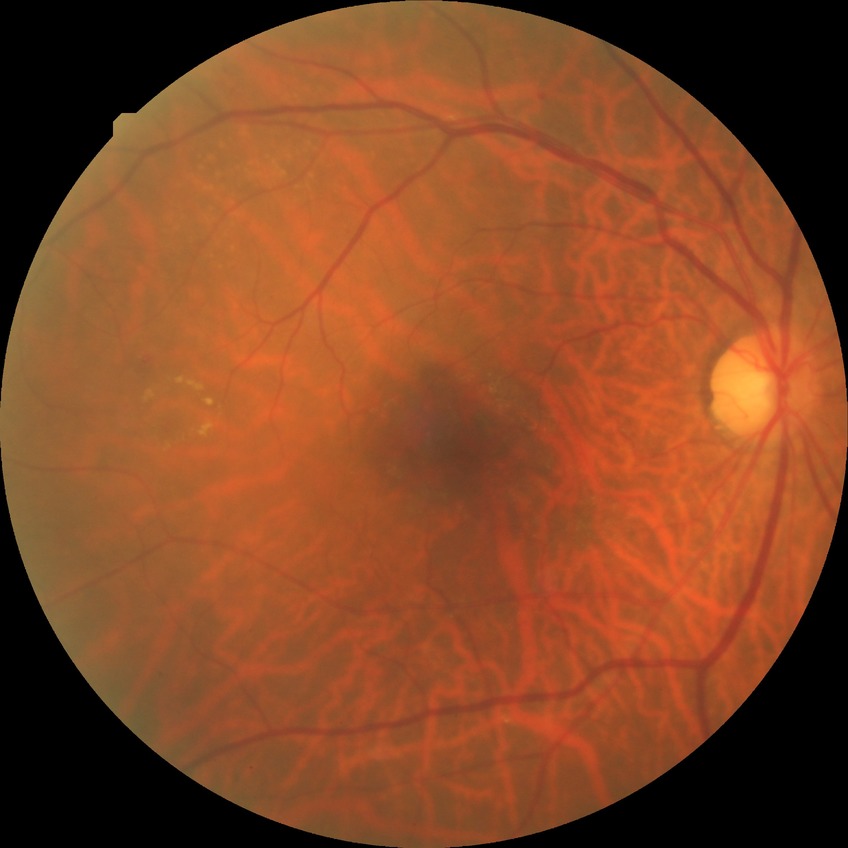 No apparent diabetic retinopathy.
Modified Davis grade is NDR.